Nonmydriatic fundus photograph, FOV: 45 degrees: 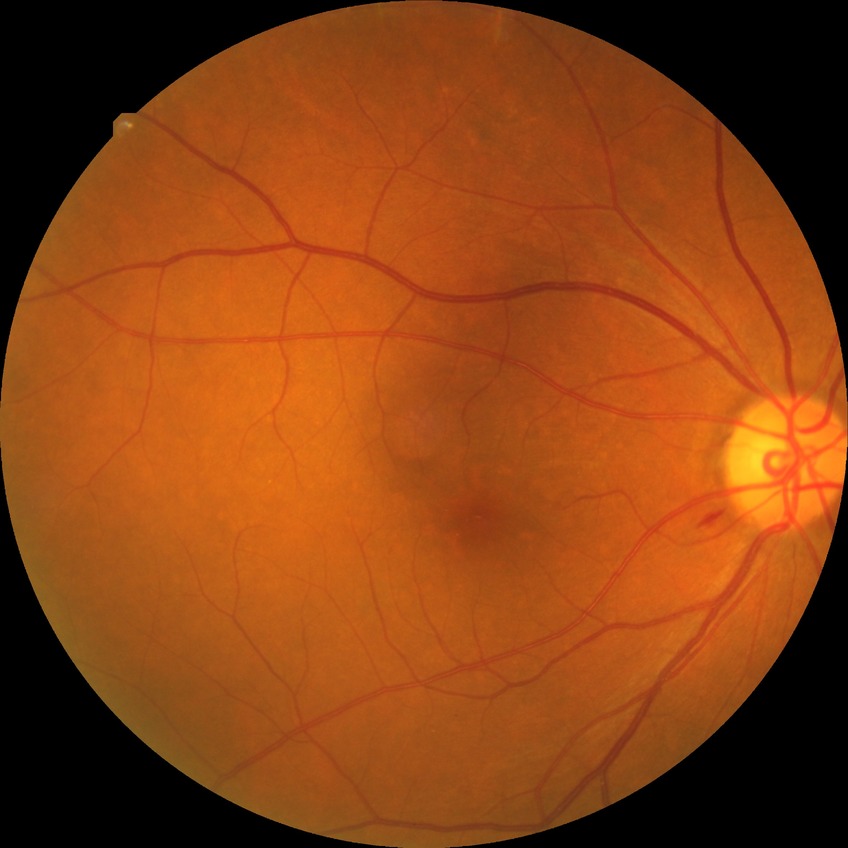
Modified Davis grading is simple diabetic retinopathy.